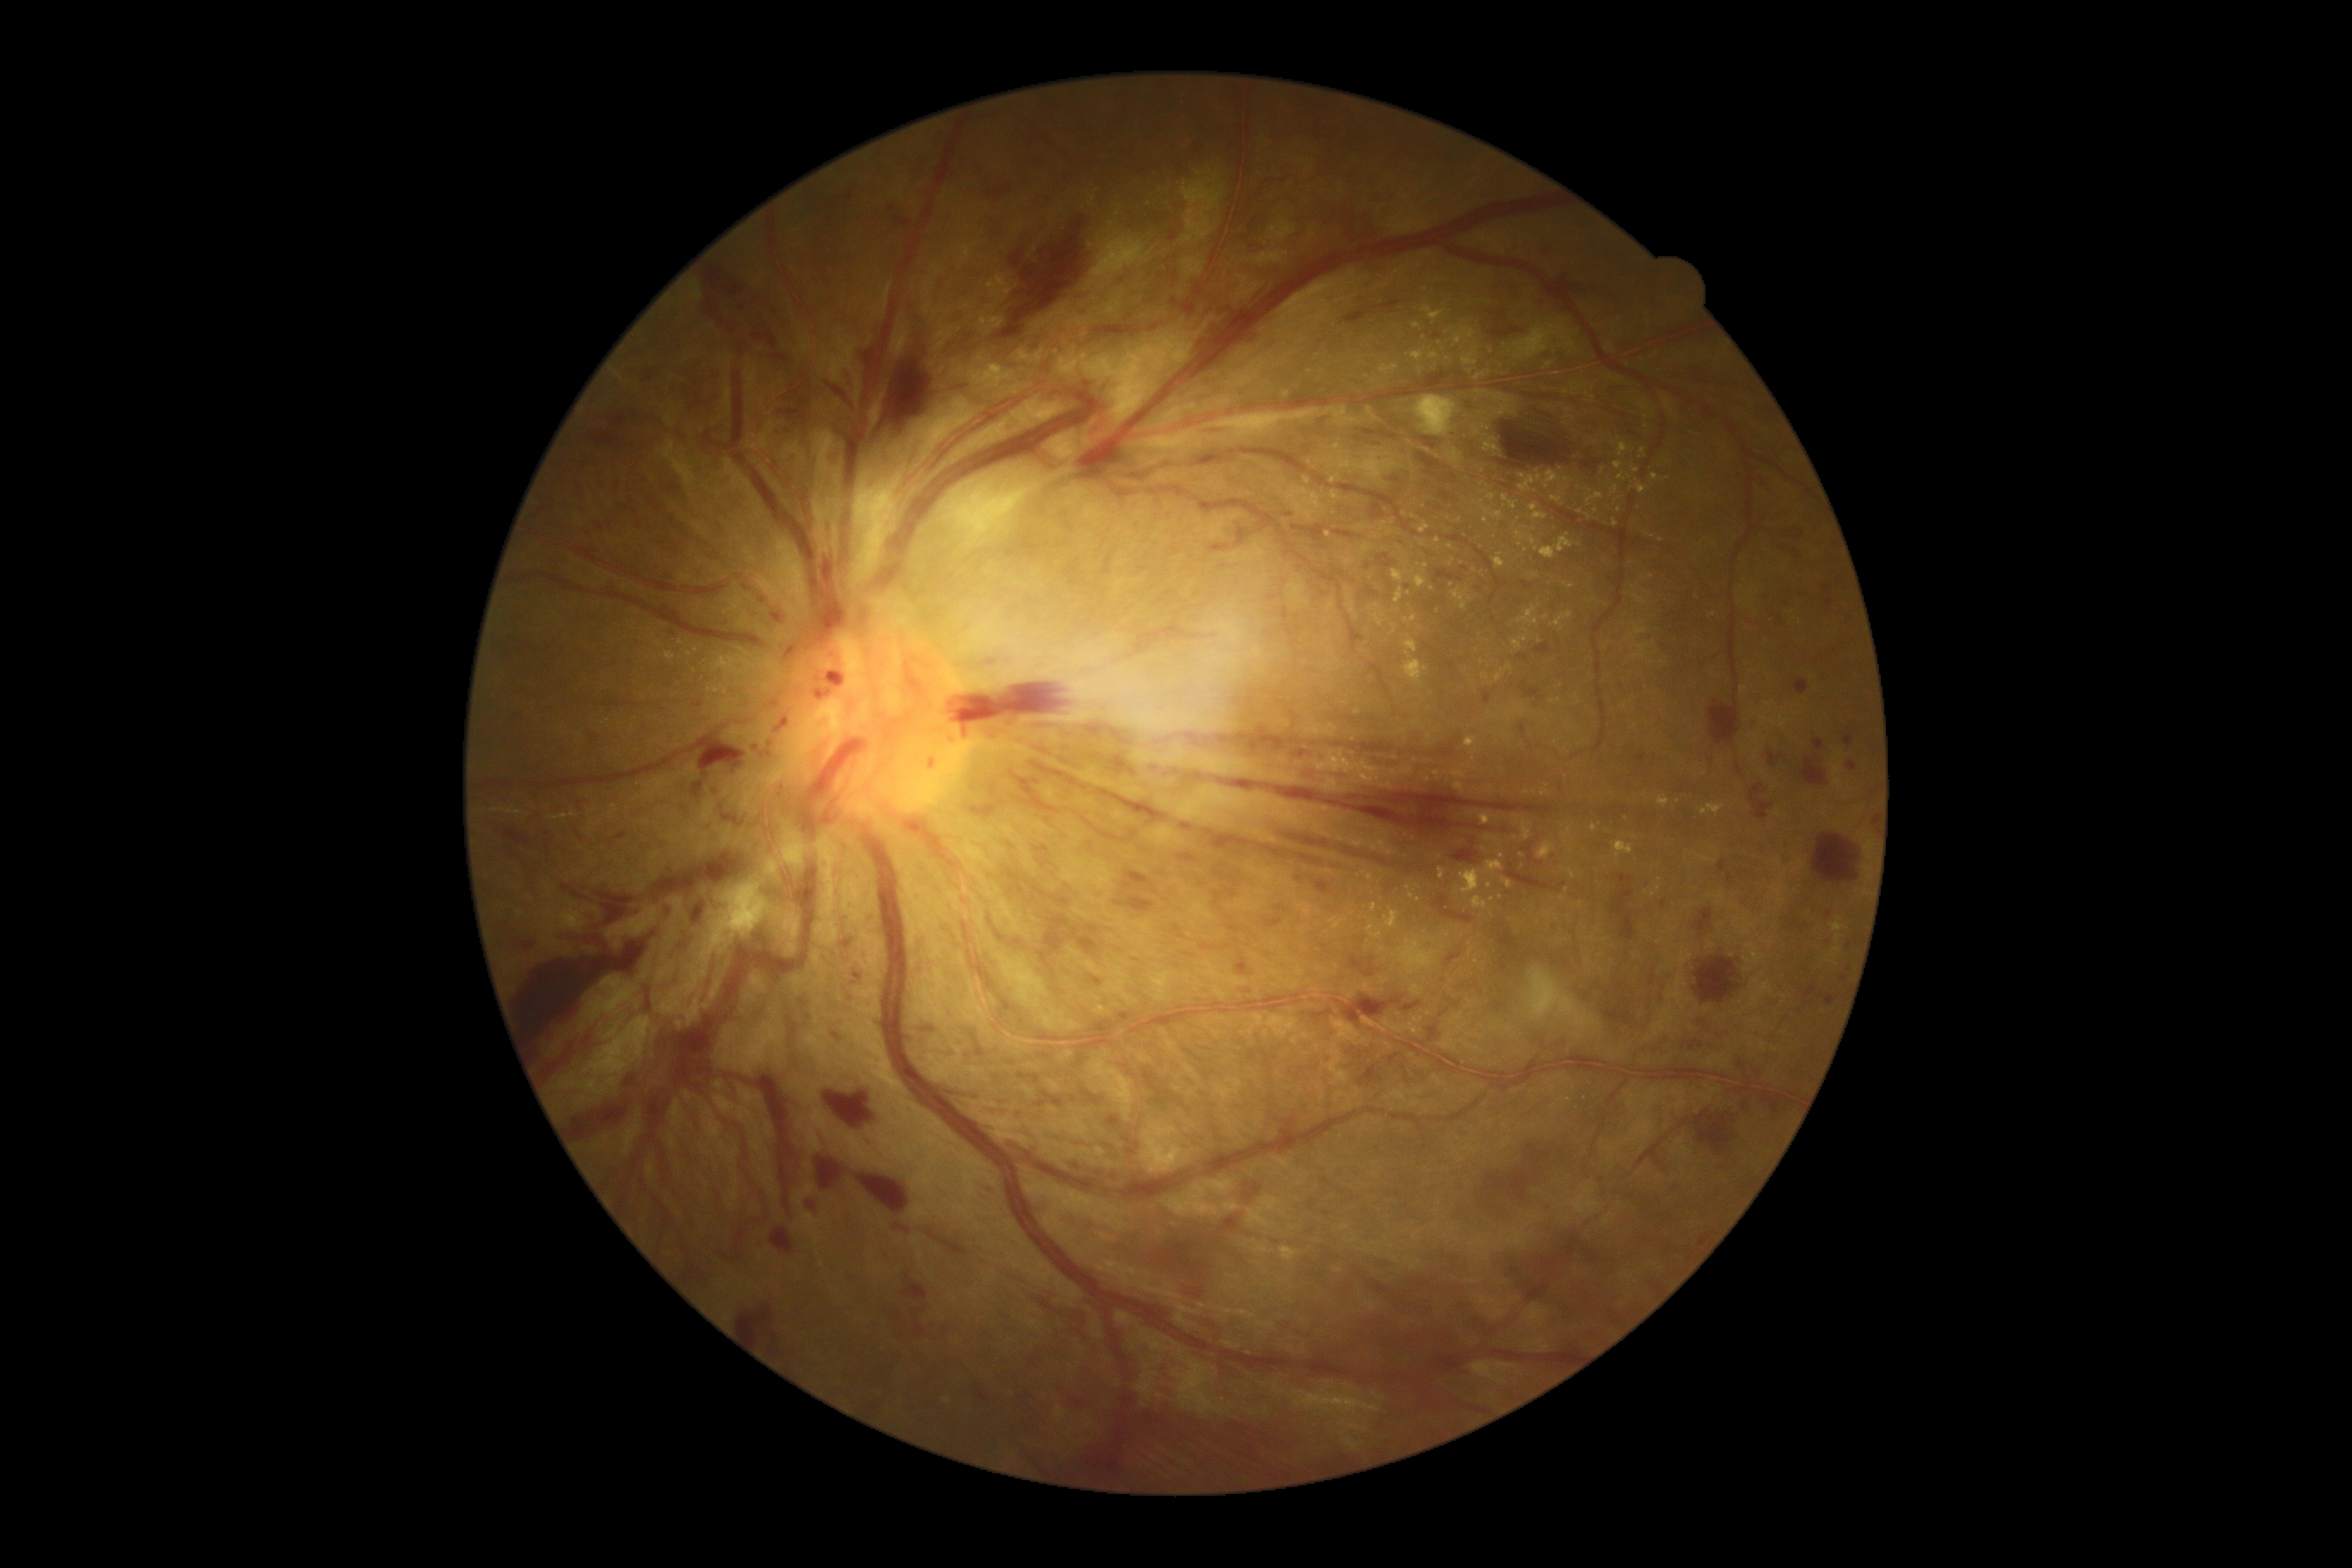

DR is PDR (grade 4).
EXs include left=991, top=364, right=1001, bottom=374 | left=1493, top=554, right=1505, bottom=570 | left=1486, top=494, right=1497, bottom=501 | left=1280, top=1246, right=1301, bottom=1256 | left=1361, top=780, right=1373, bottom=787 | left=1476, top=501, right=1504, bottom=520 | left=1381, top=522, right=1392, bottom=536 | left=1543, top=472, right=1562, bottom=489 | left=1476, top=374, right=1485, bottom=381.
Smaller EXs around (1459,521) | (575,815) | (1438,541) | (1476,960) | (1713,615) | (1596,512) | (1561,469) | (1553,702) | (1354,740) | (1605,559) | (1477,432).
HEs include left=1110, top=756, right=1136, bottom=775 | left=1553, top=922, right=1557, bottom=931 | left=1536, top=644, right=1550, bottom=654 | left=513, top=714, right=525, bottom=723 | left=869, top=300, right=965, bottom=444 | left=1366, top=443, right=1383, bottom=448 | left=940, top=328, right=981, bottom=364 | left=1440, top=1010, right=1449, bottom=1017 | left=1749, top=718, right=1761, bottom=732 | left=1316, top=881, right=1330, bottom=895 | left=1182, top=1285, right=1201, bottom=1297 | left=1445, top=952, right=1462, bottom=967 | left=505, top=830, right=529, bottom=845 | left=1694, top=959, right=1741, bottom=1003 | left=1344, top=848, right=1390, bottom=867 | left=1368, top=957, right=1376, bottom=965 | left=891, top=214, right=910, bottom=230 | left=902, top=1275, right=928, bottom=1301.
Smaller HEs around (1797,554).